CFP: 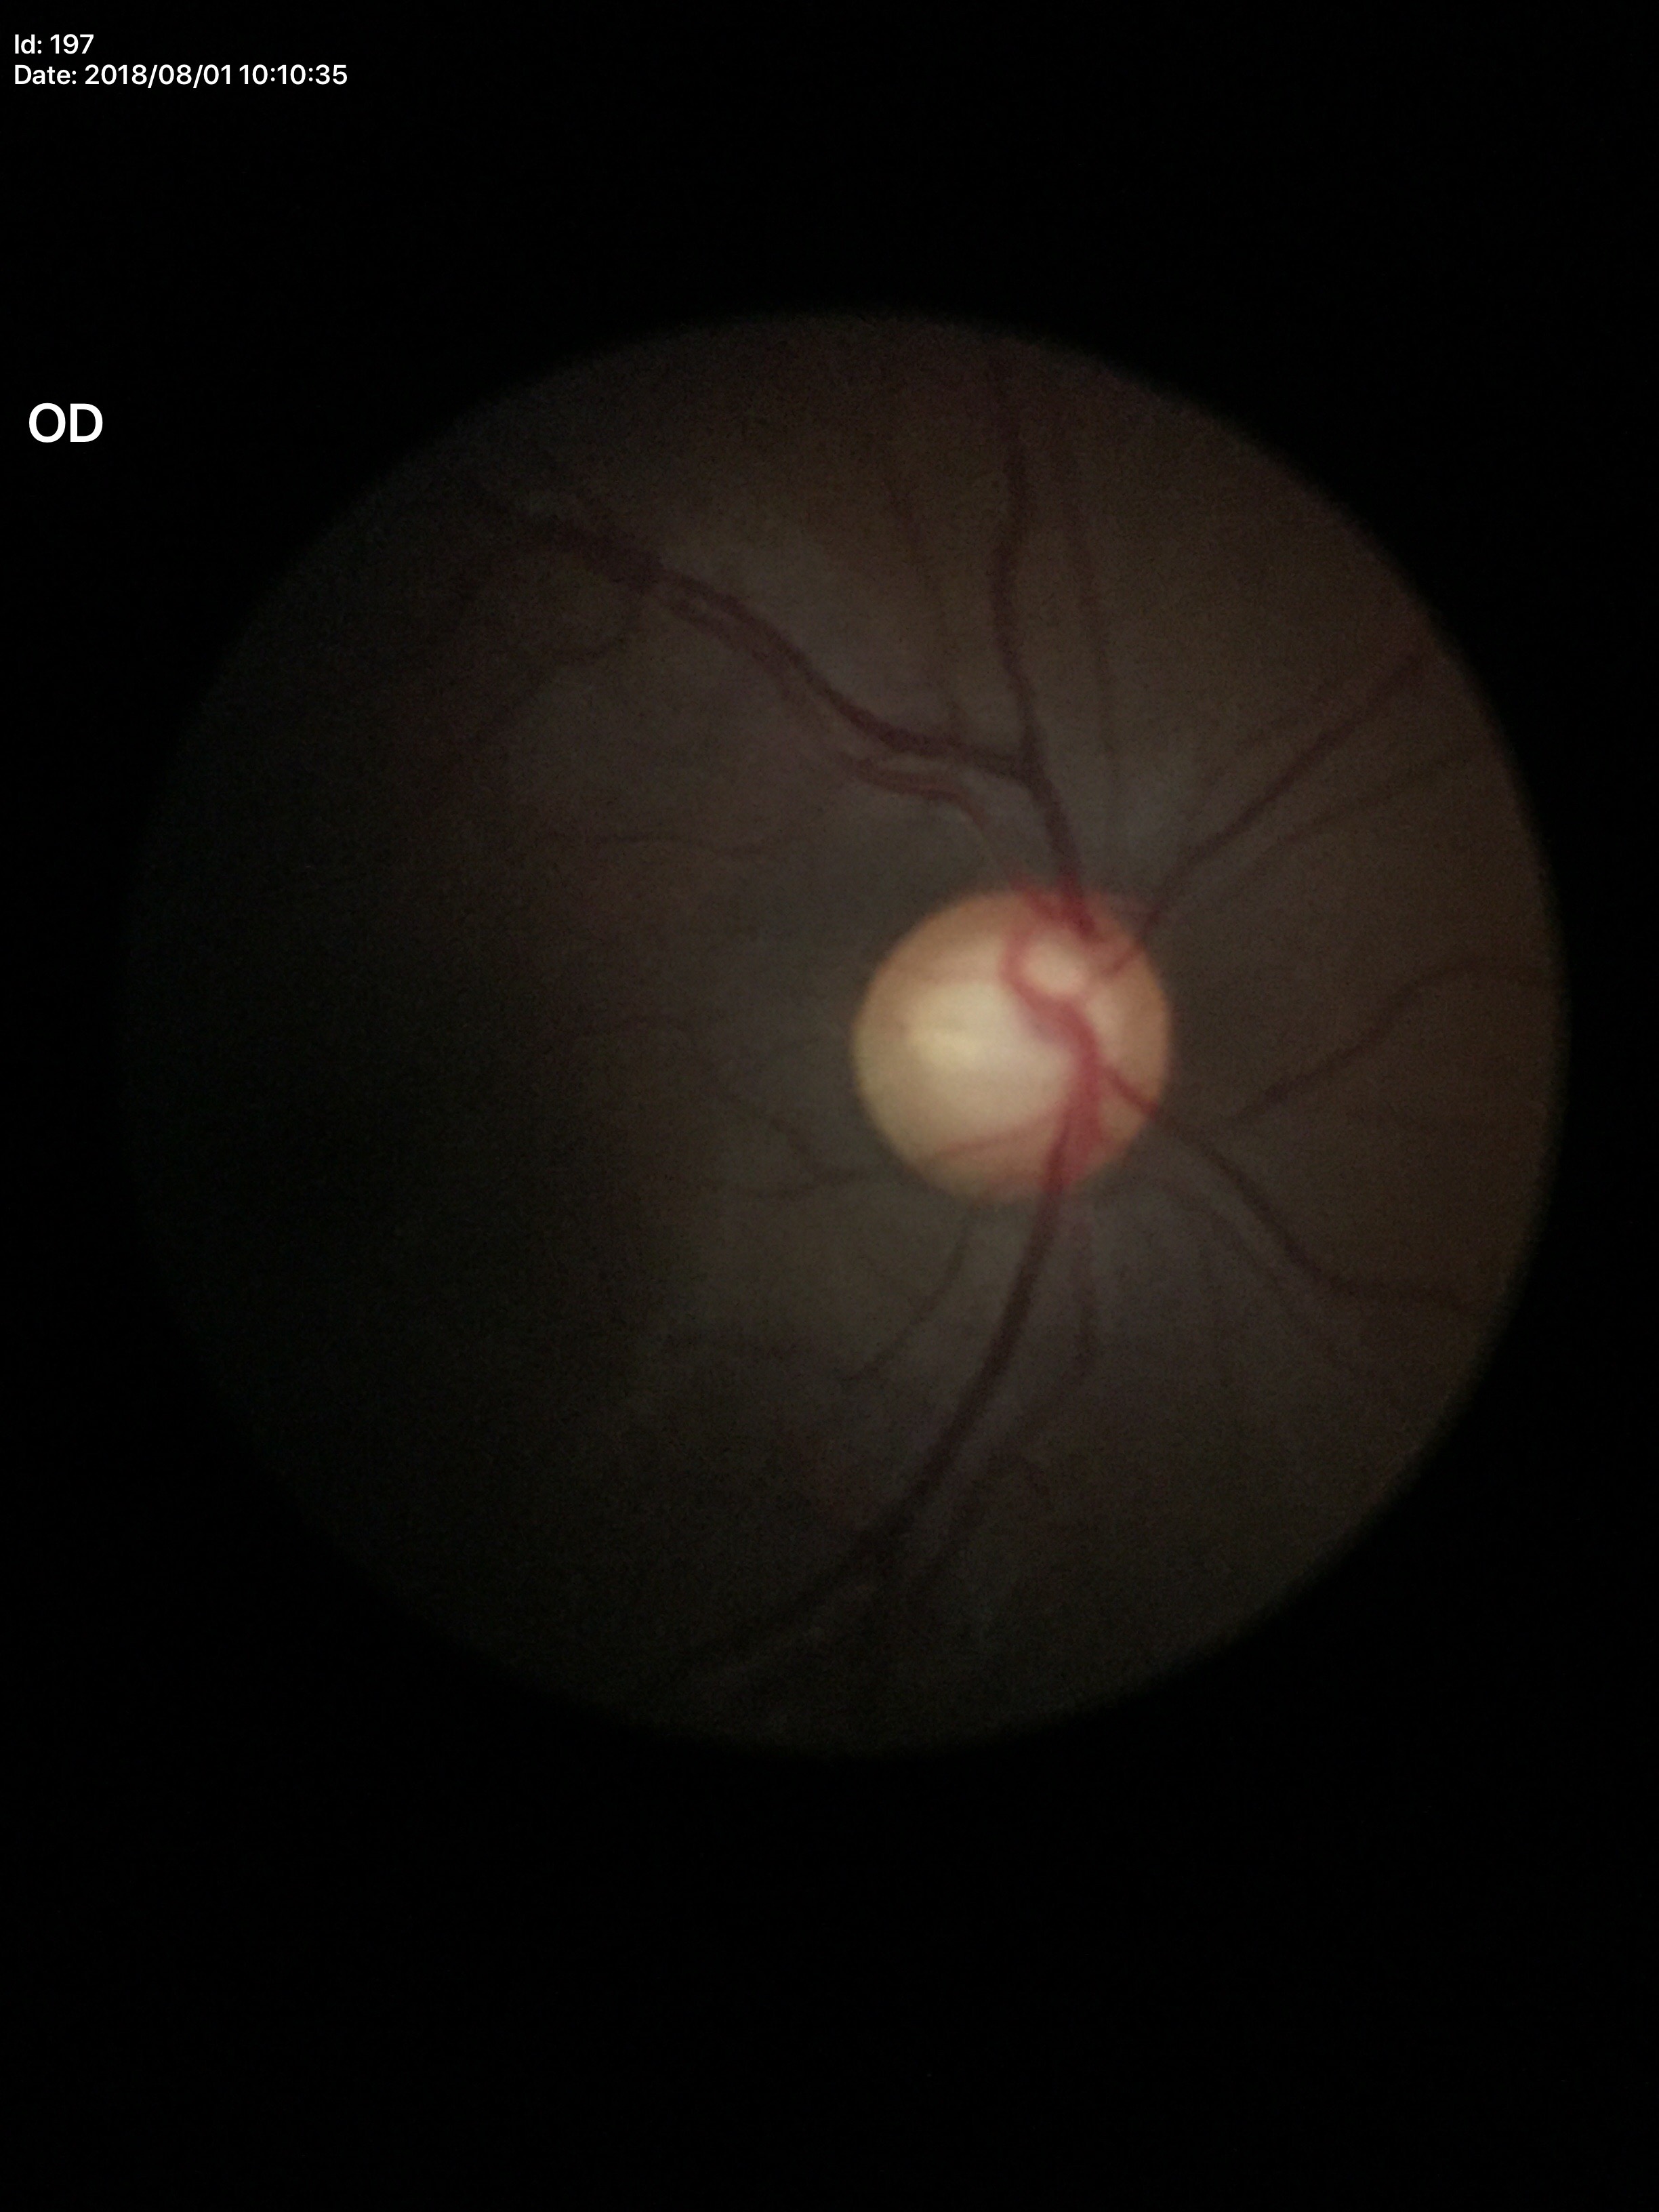
Q: What is the VCDR?
A: 0.66
Q: What is the glaucoma assessment?
A: suspicious